Retinal fundus photograph; mydriatic (tropicamide and phenylephrine); FOV: 50 degrees: 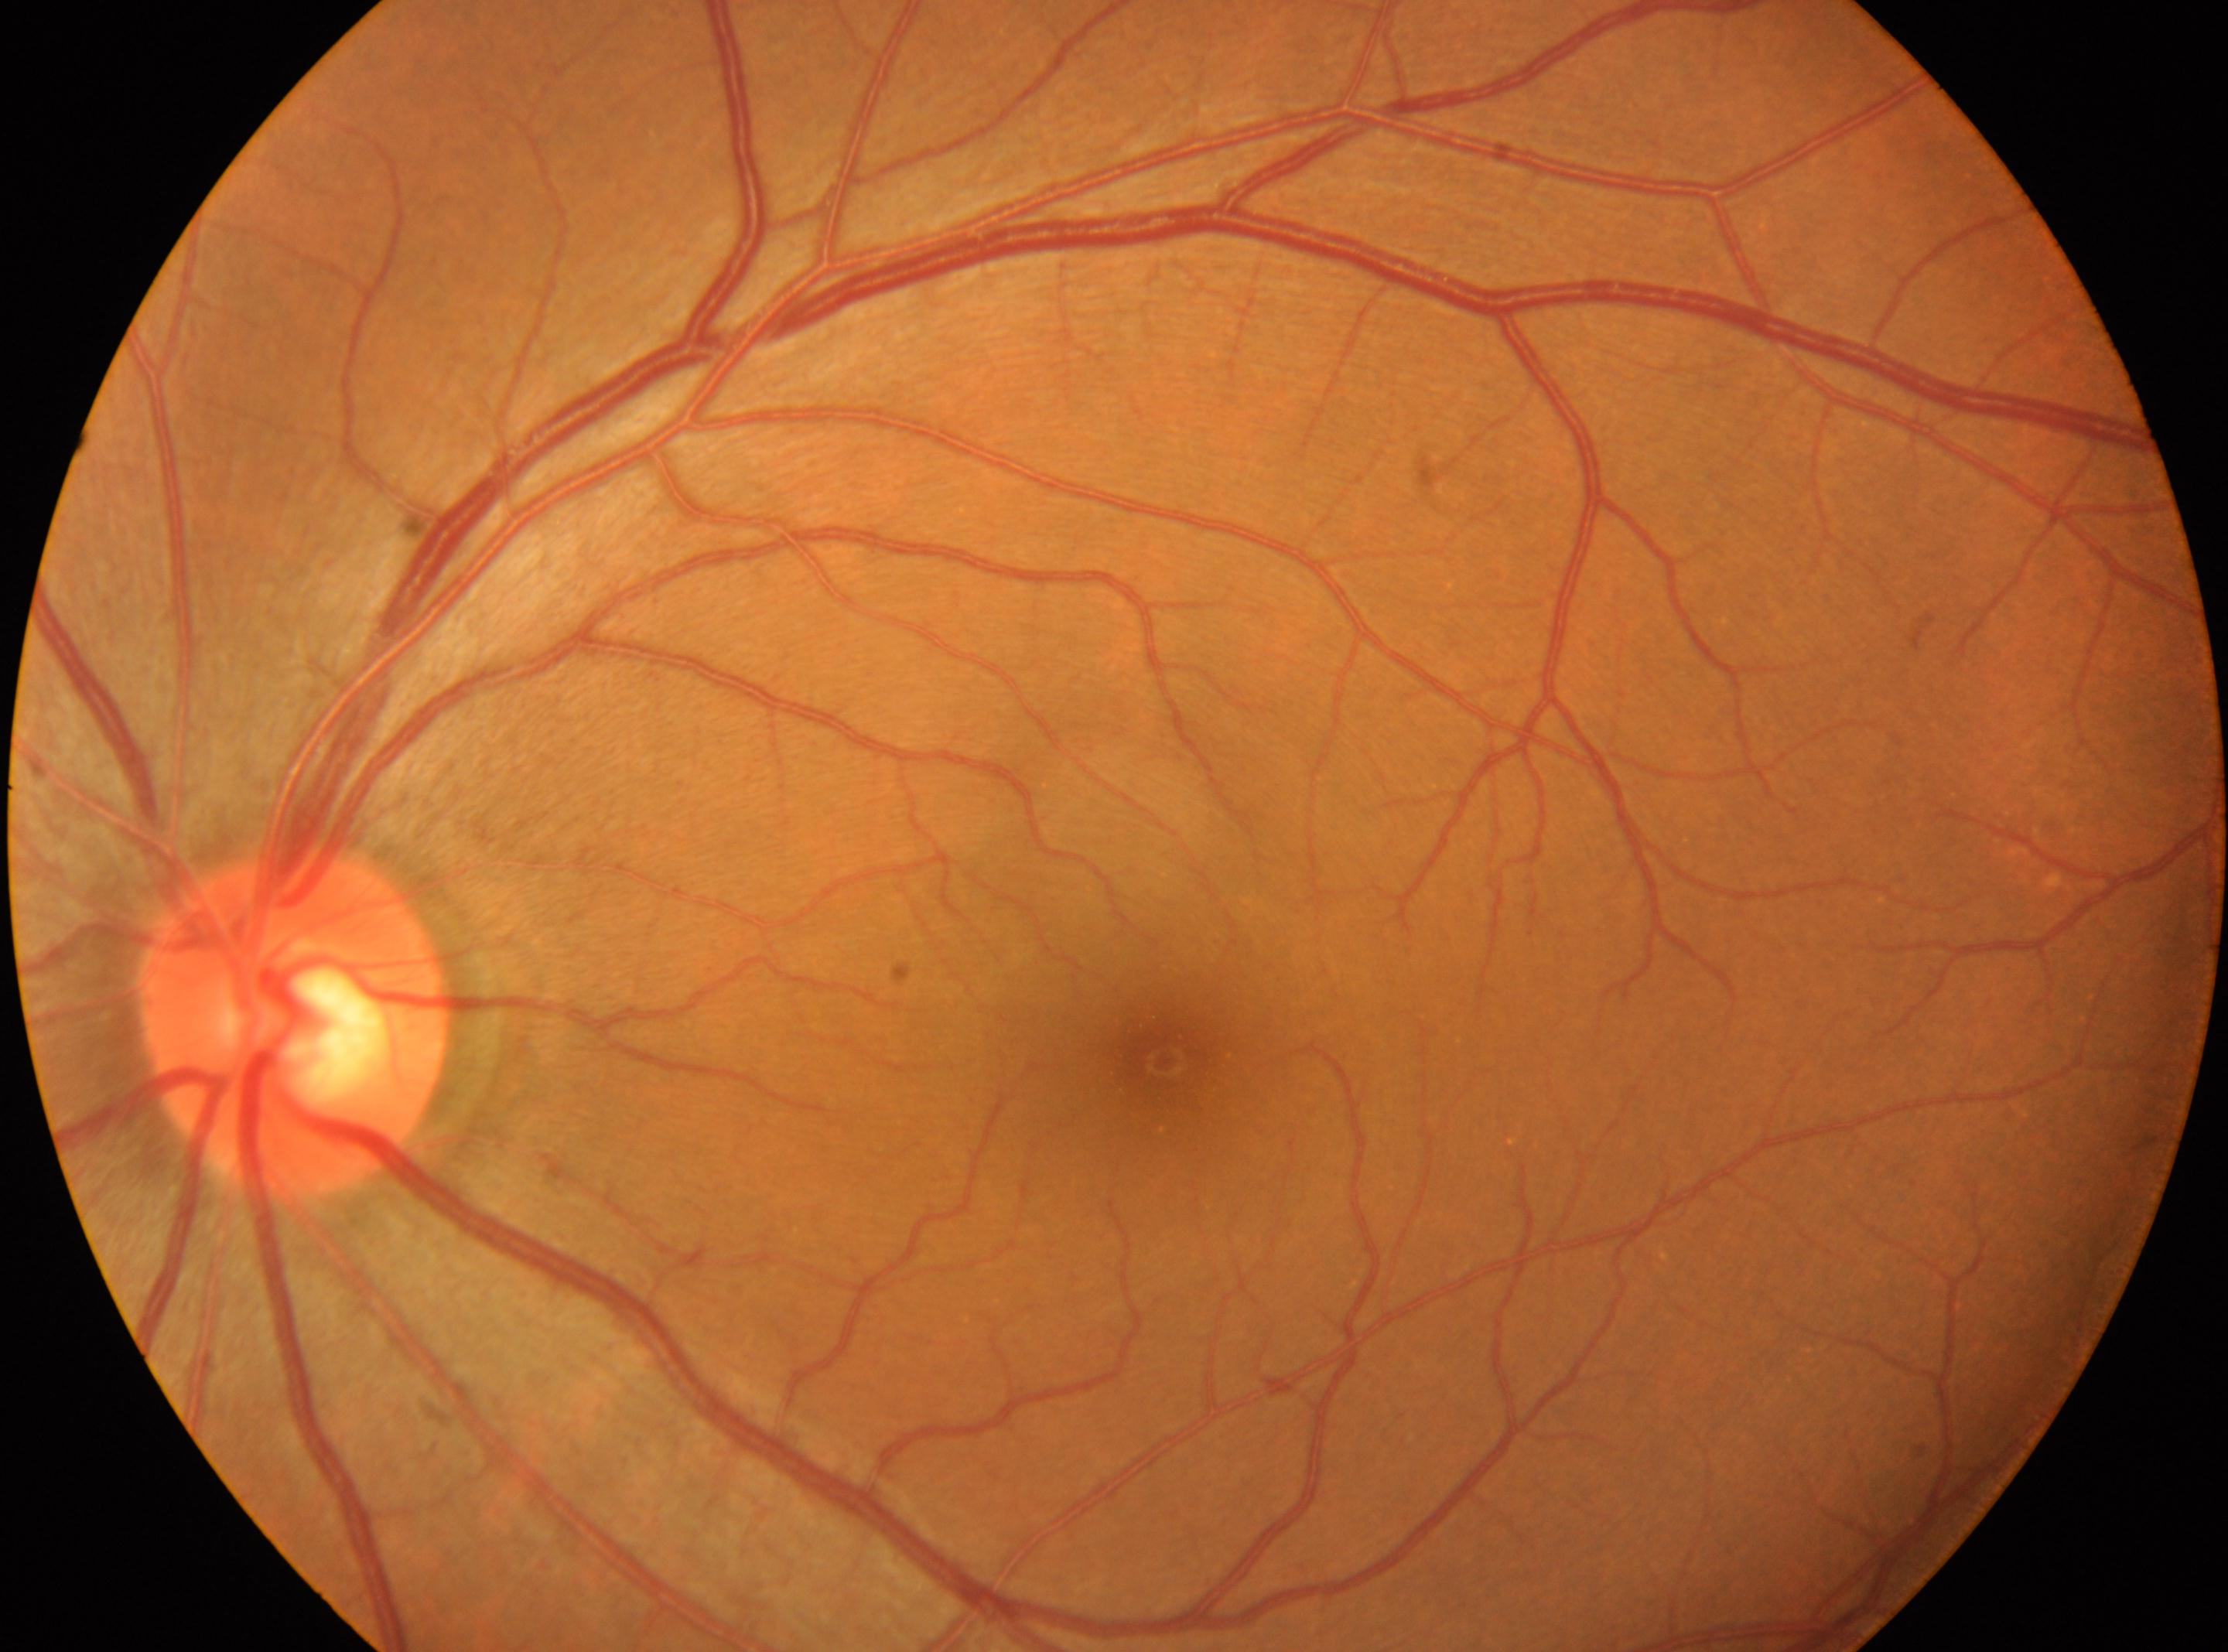 Annotations:
– retinopathy grade: 0 (no apparent retinopathy)
– ONH: 297px, 1022px
– laterality: left
– fovea: 1162px, 1060px